Pediatric retinal photograph (wide-field) — 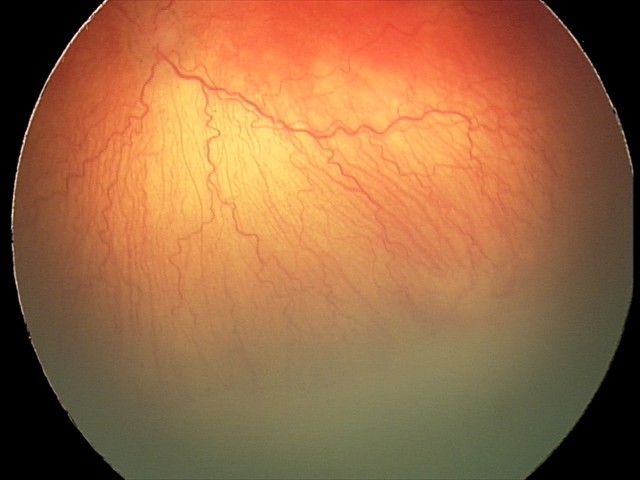 Diagnosis: aggressive retinopathy of prematurity — rapidly progressive severe ROP with prominent plus disease, often without classic stage progression, plus disease: present.